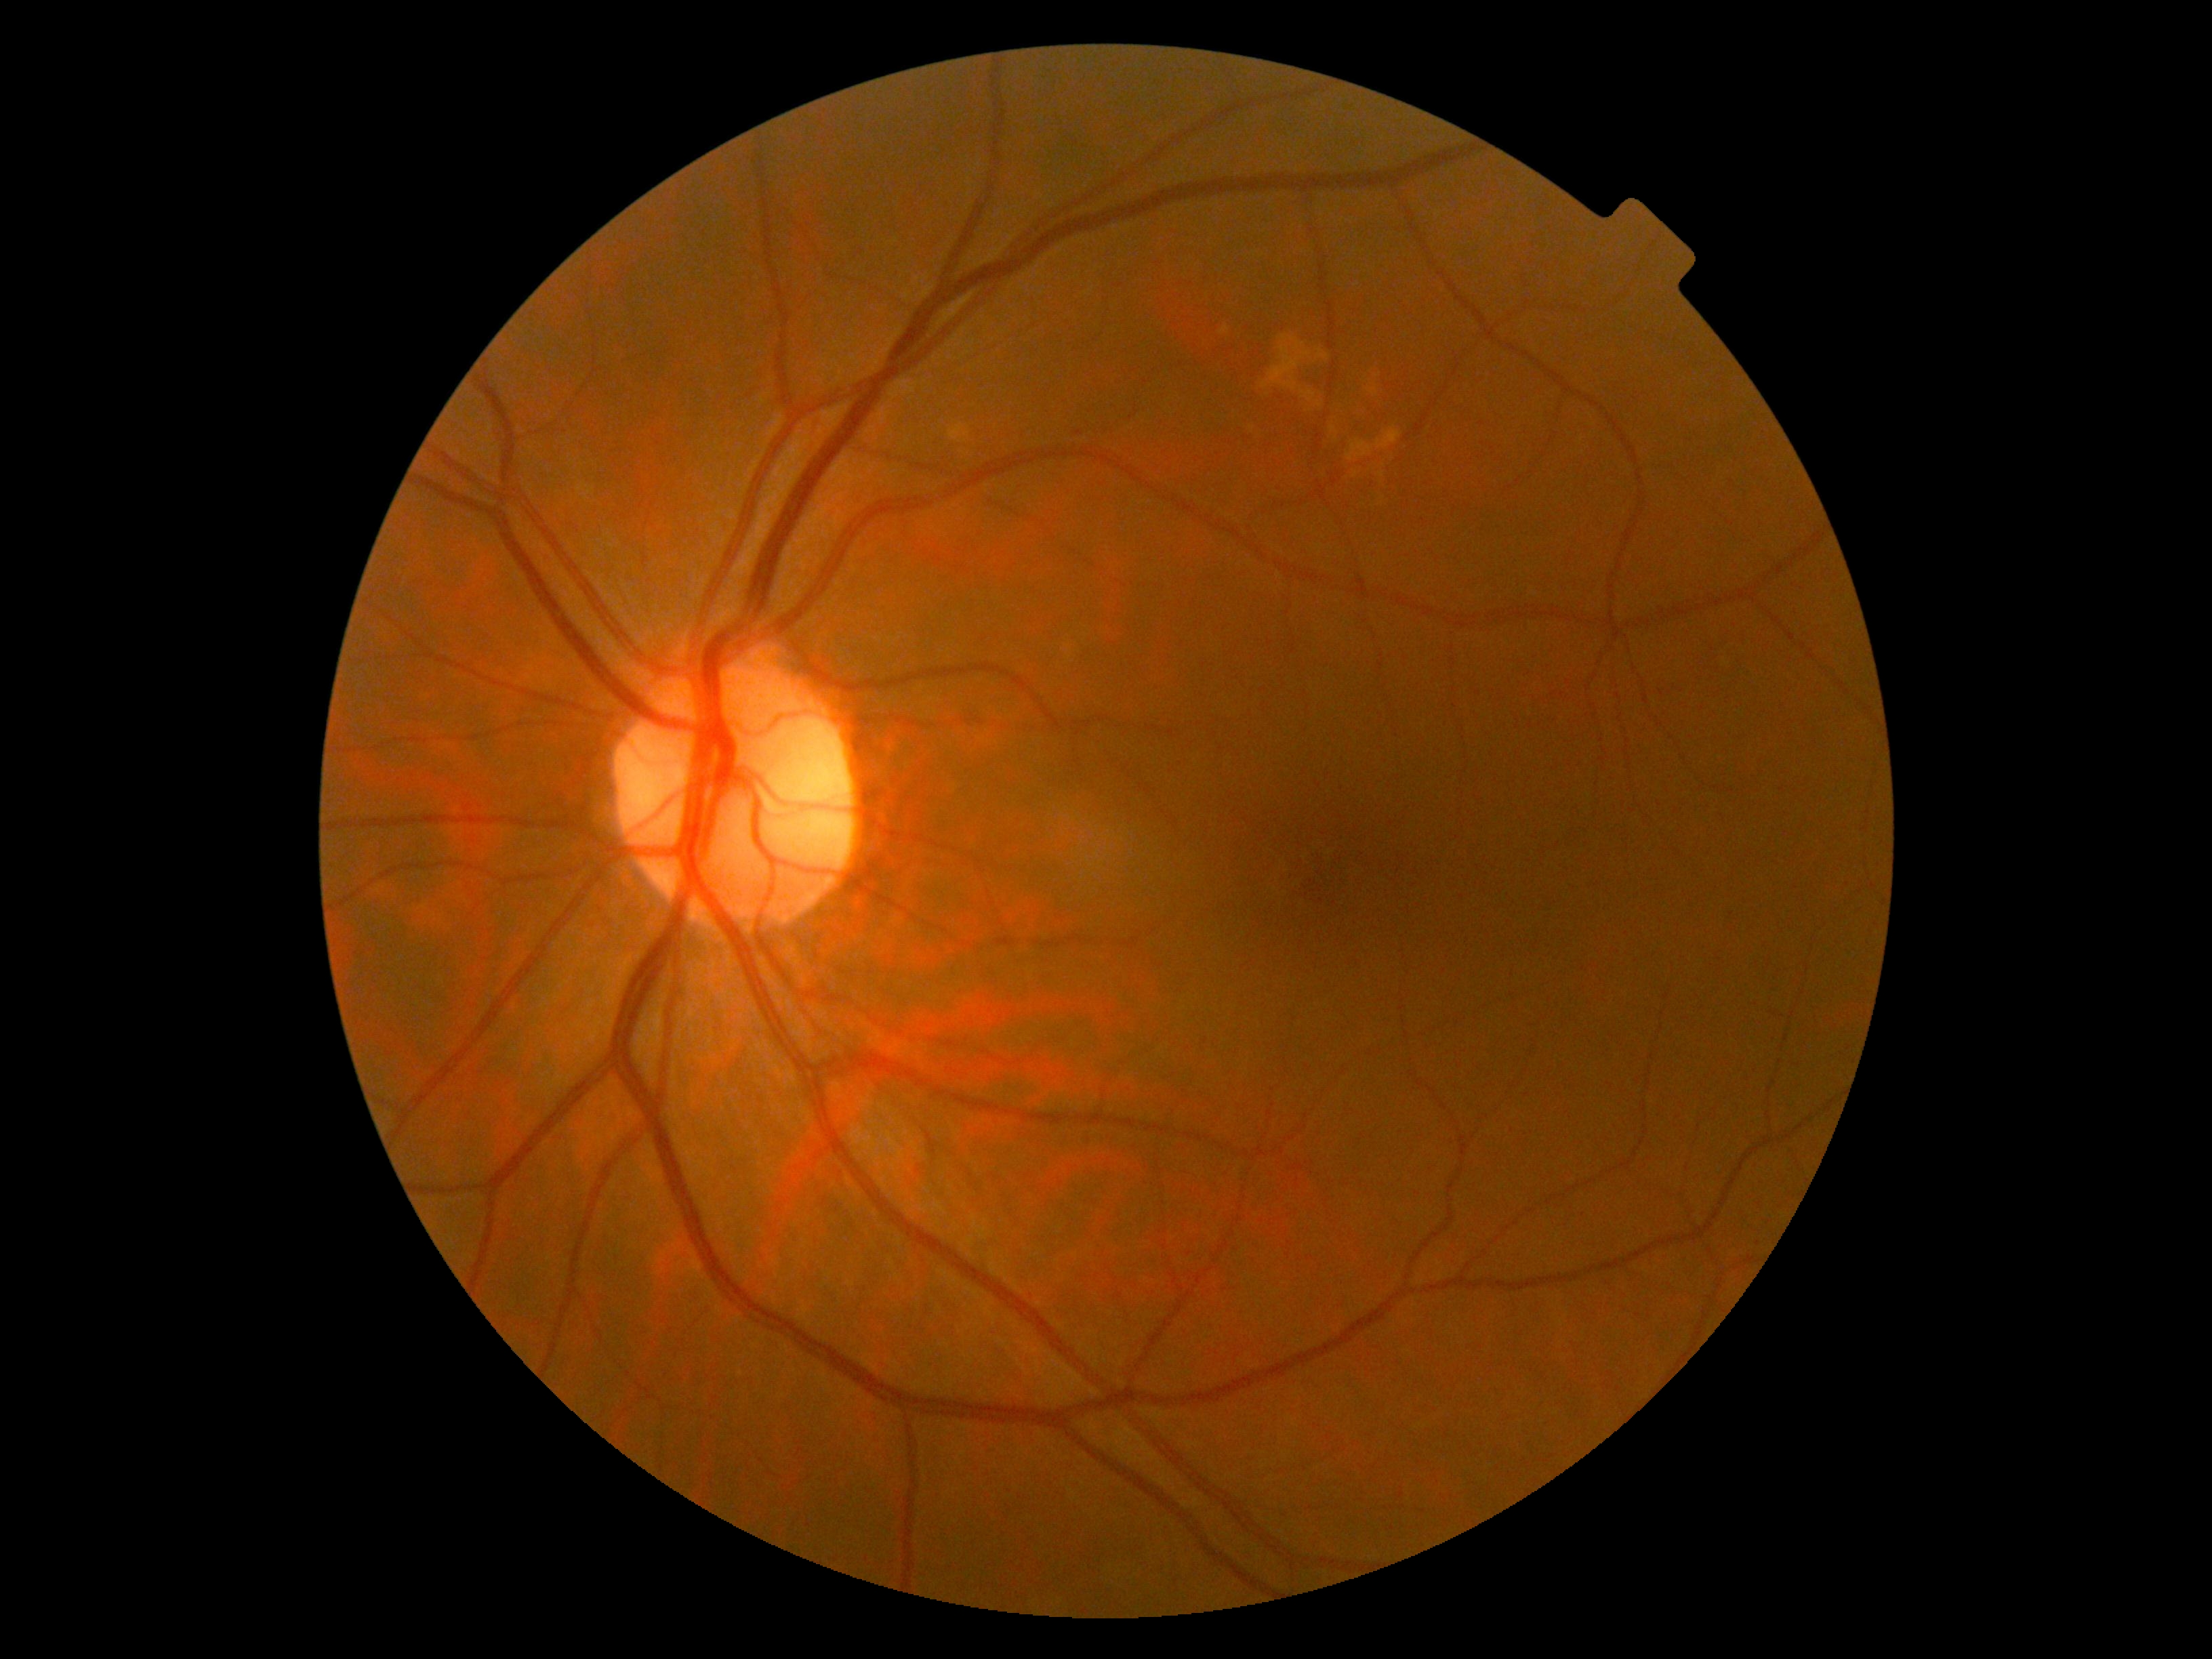 DR: grade 0
DR impression: no apparent DR